Without pupil dilation · 848 by 848 pixels · DR severity per modified Davis staging · acquired with a NIDEK AFC-230 · 45° field of view.
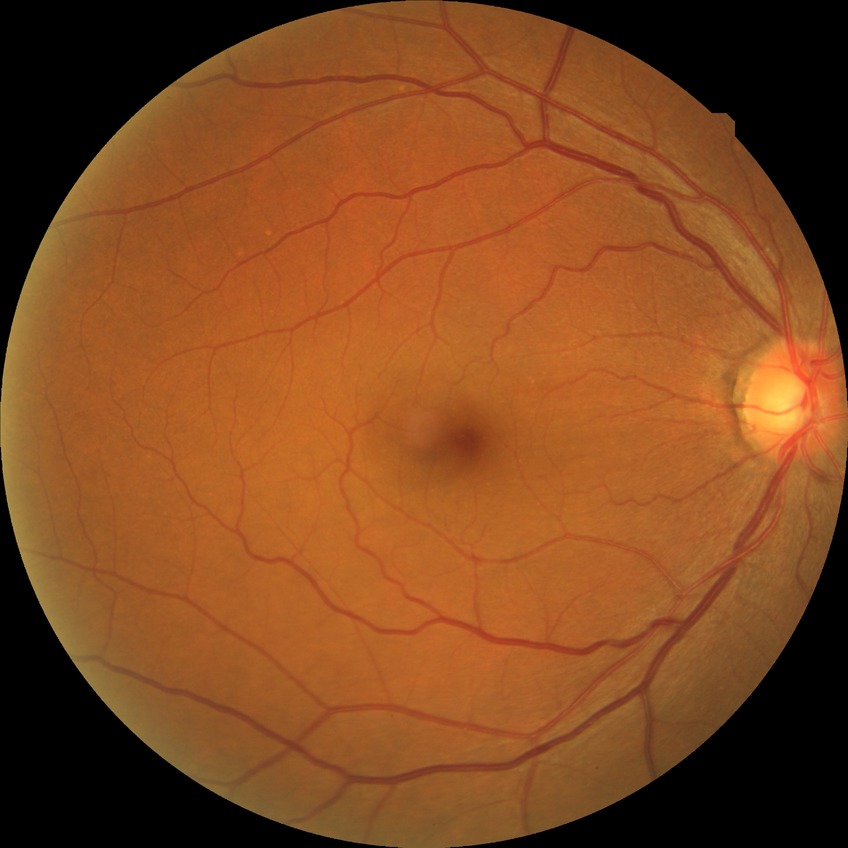
Retinopathy stage is no diabetic retinopathy.